45-degree field of view — 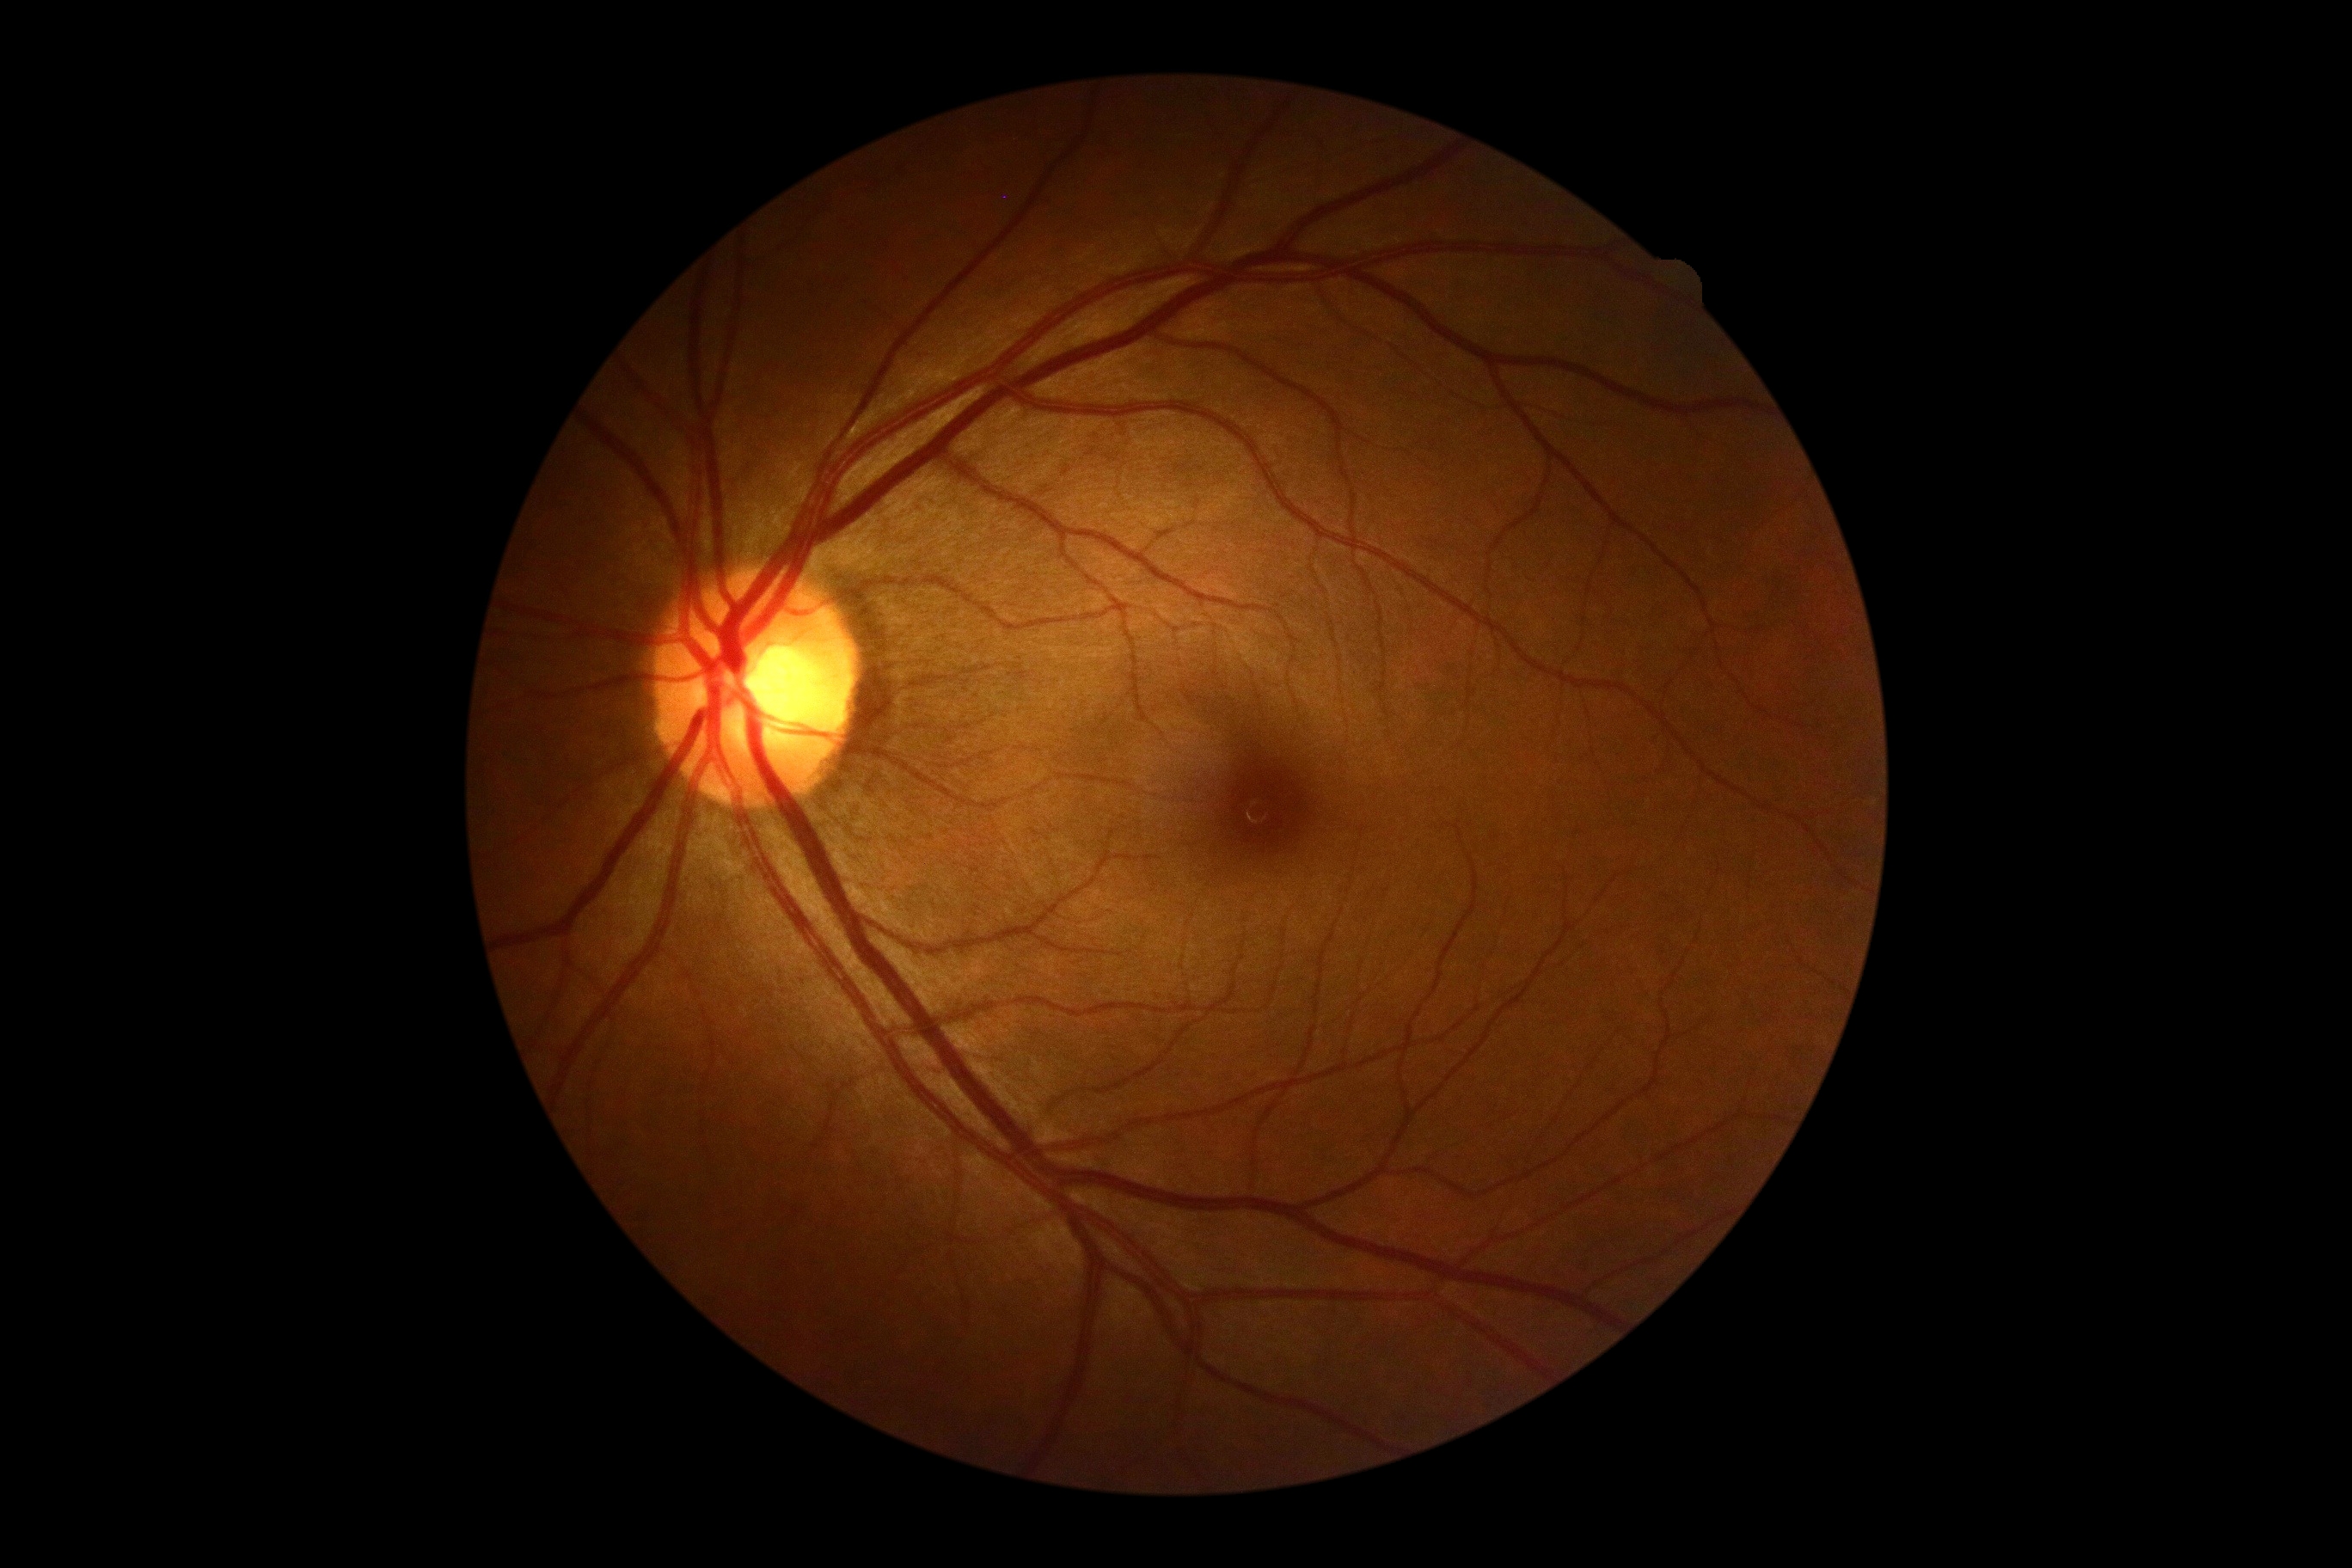 Findings:
• diabetic retinopathy grade — 0 — no visible signs of diabetic retinopathy